Fundus photo, 1534x1534, 50° FOV:
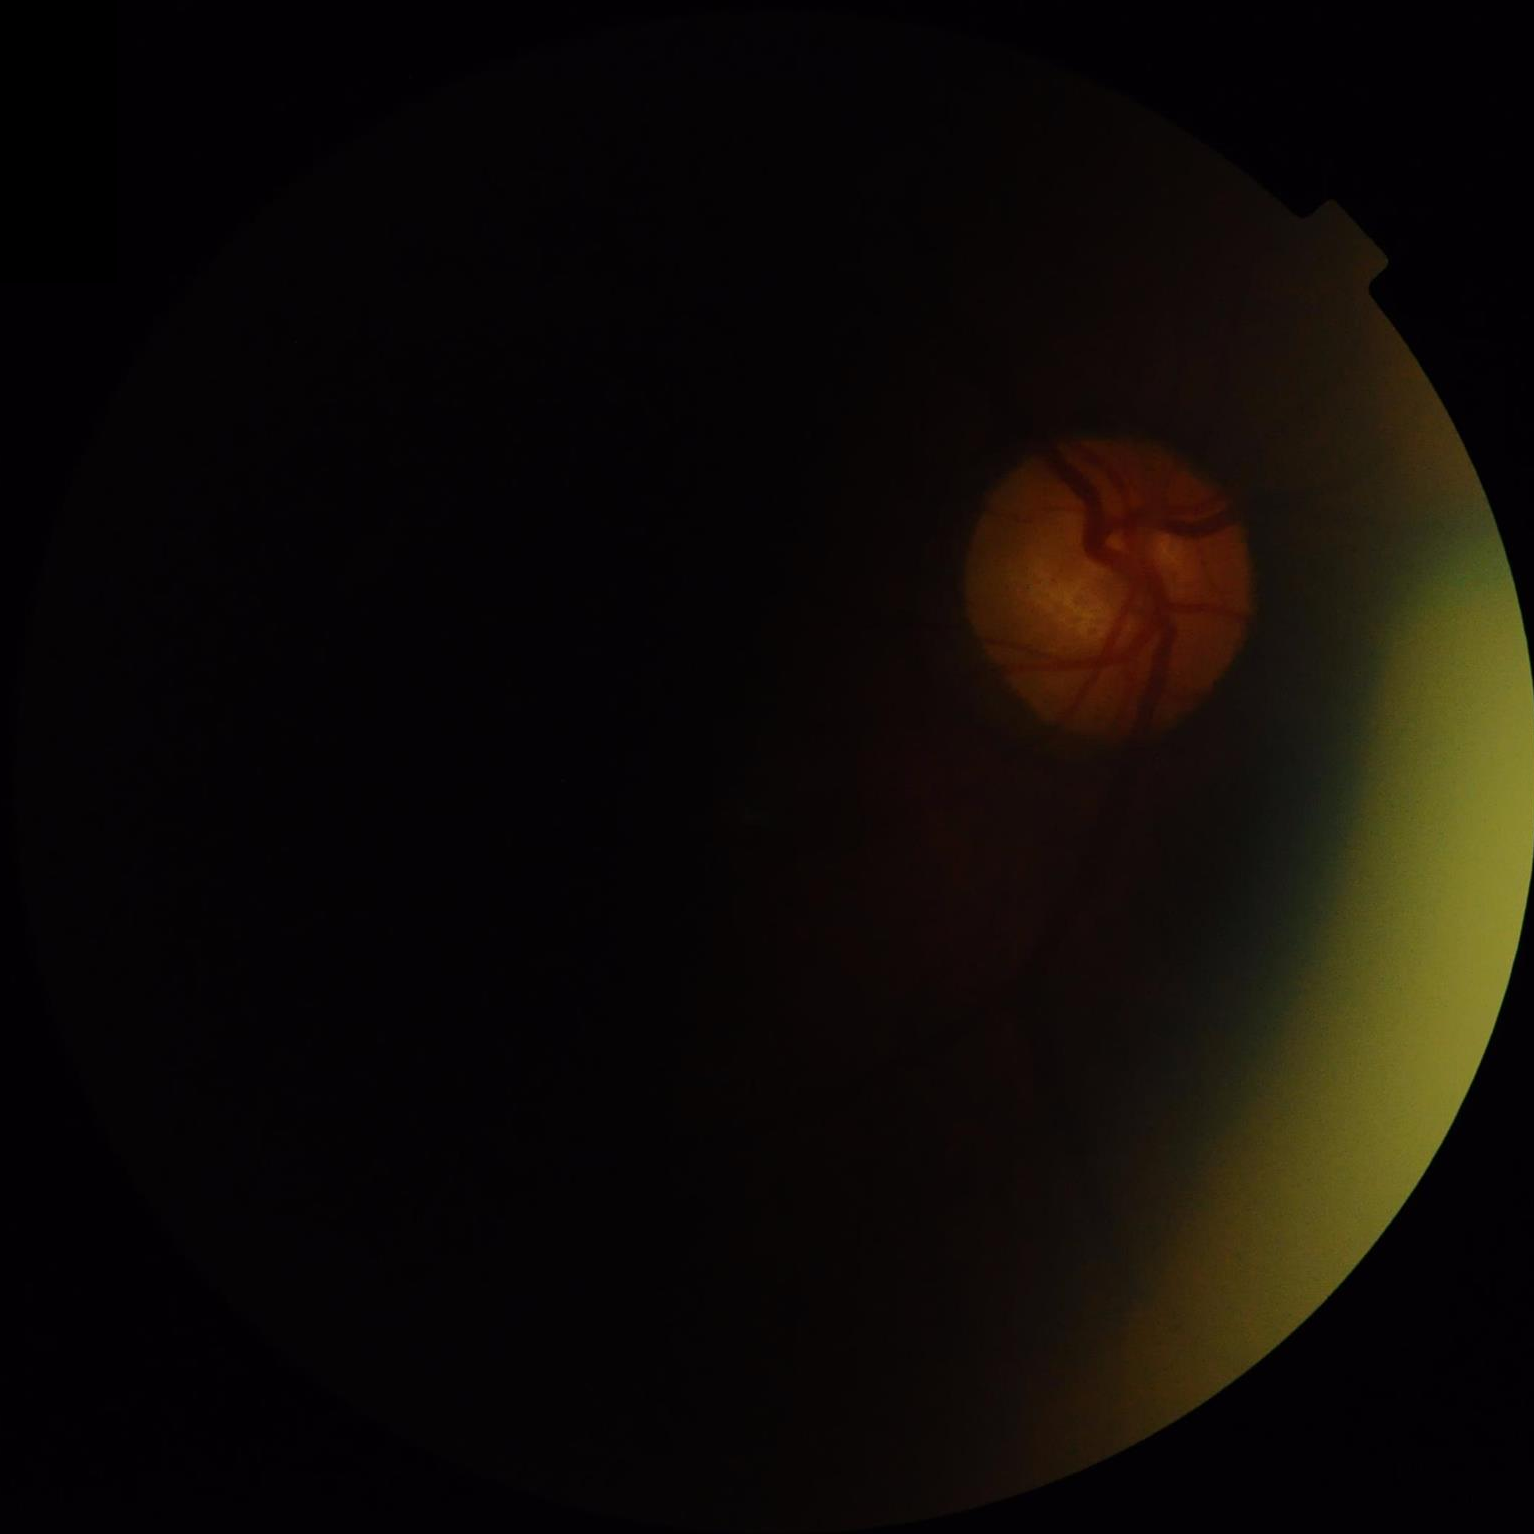

Contrast: poor dynamic range
Illumination: uneven illumination or color cast
Sharpness: out of focus, structures indistinct
Overall: poor and difficult to use diagnostically